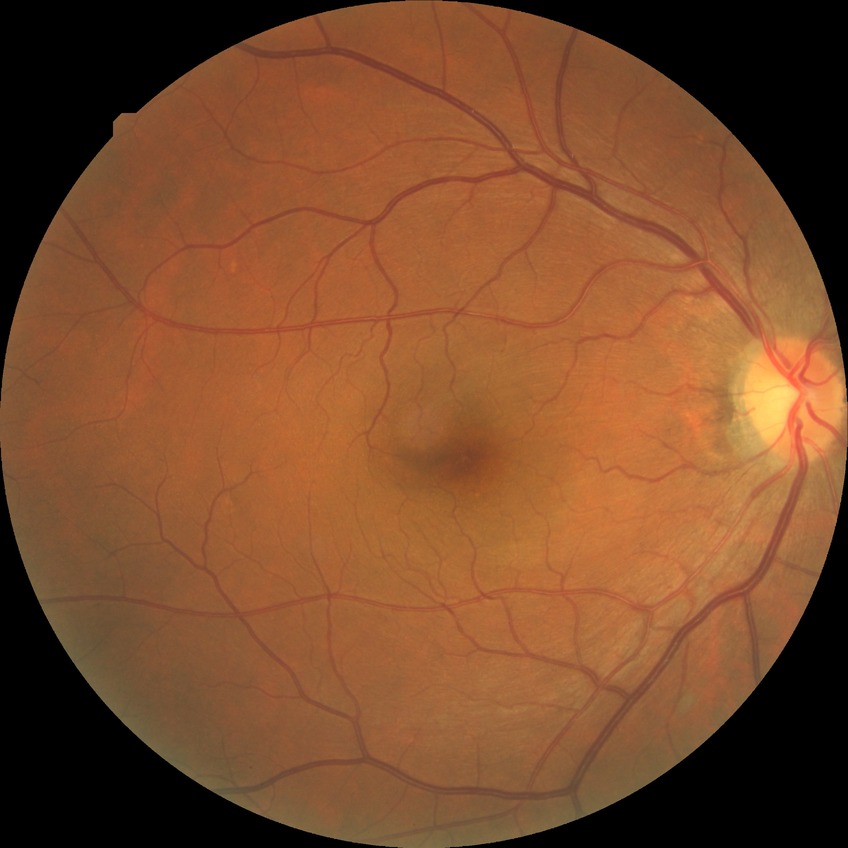 Findings:
* diabetic retinopathy (DR) — NDR (no diabetic retinopathy)